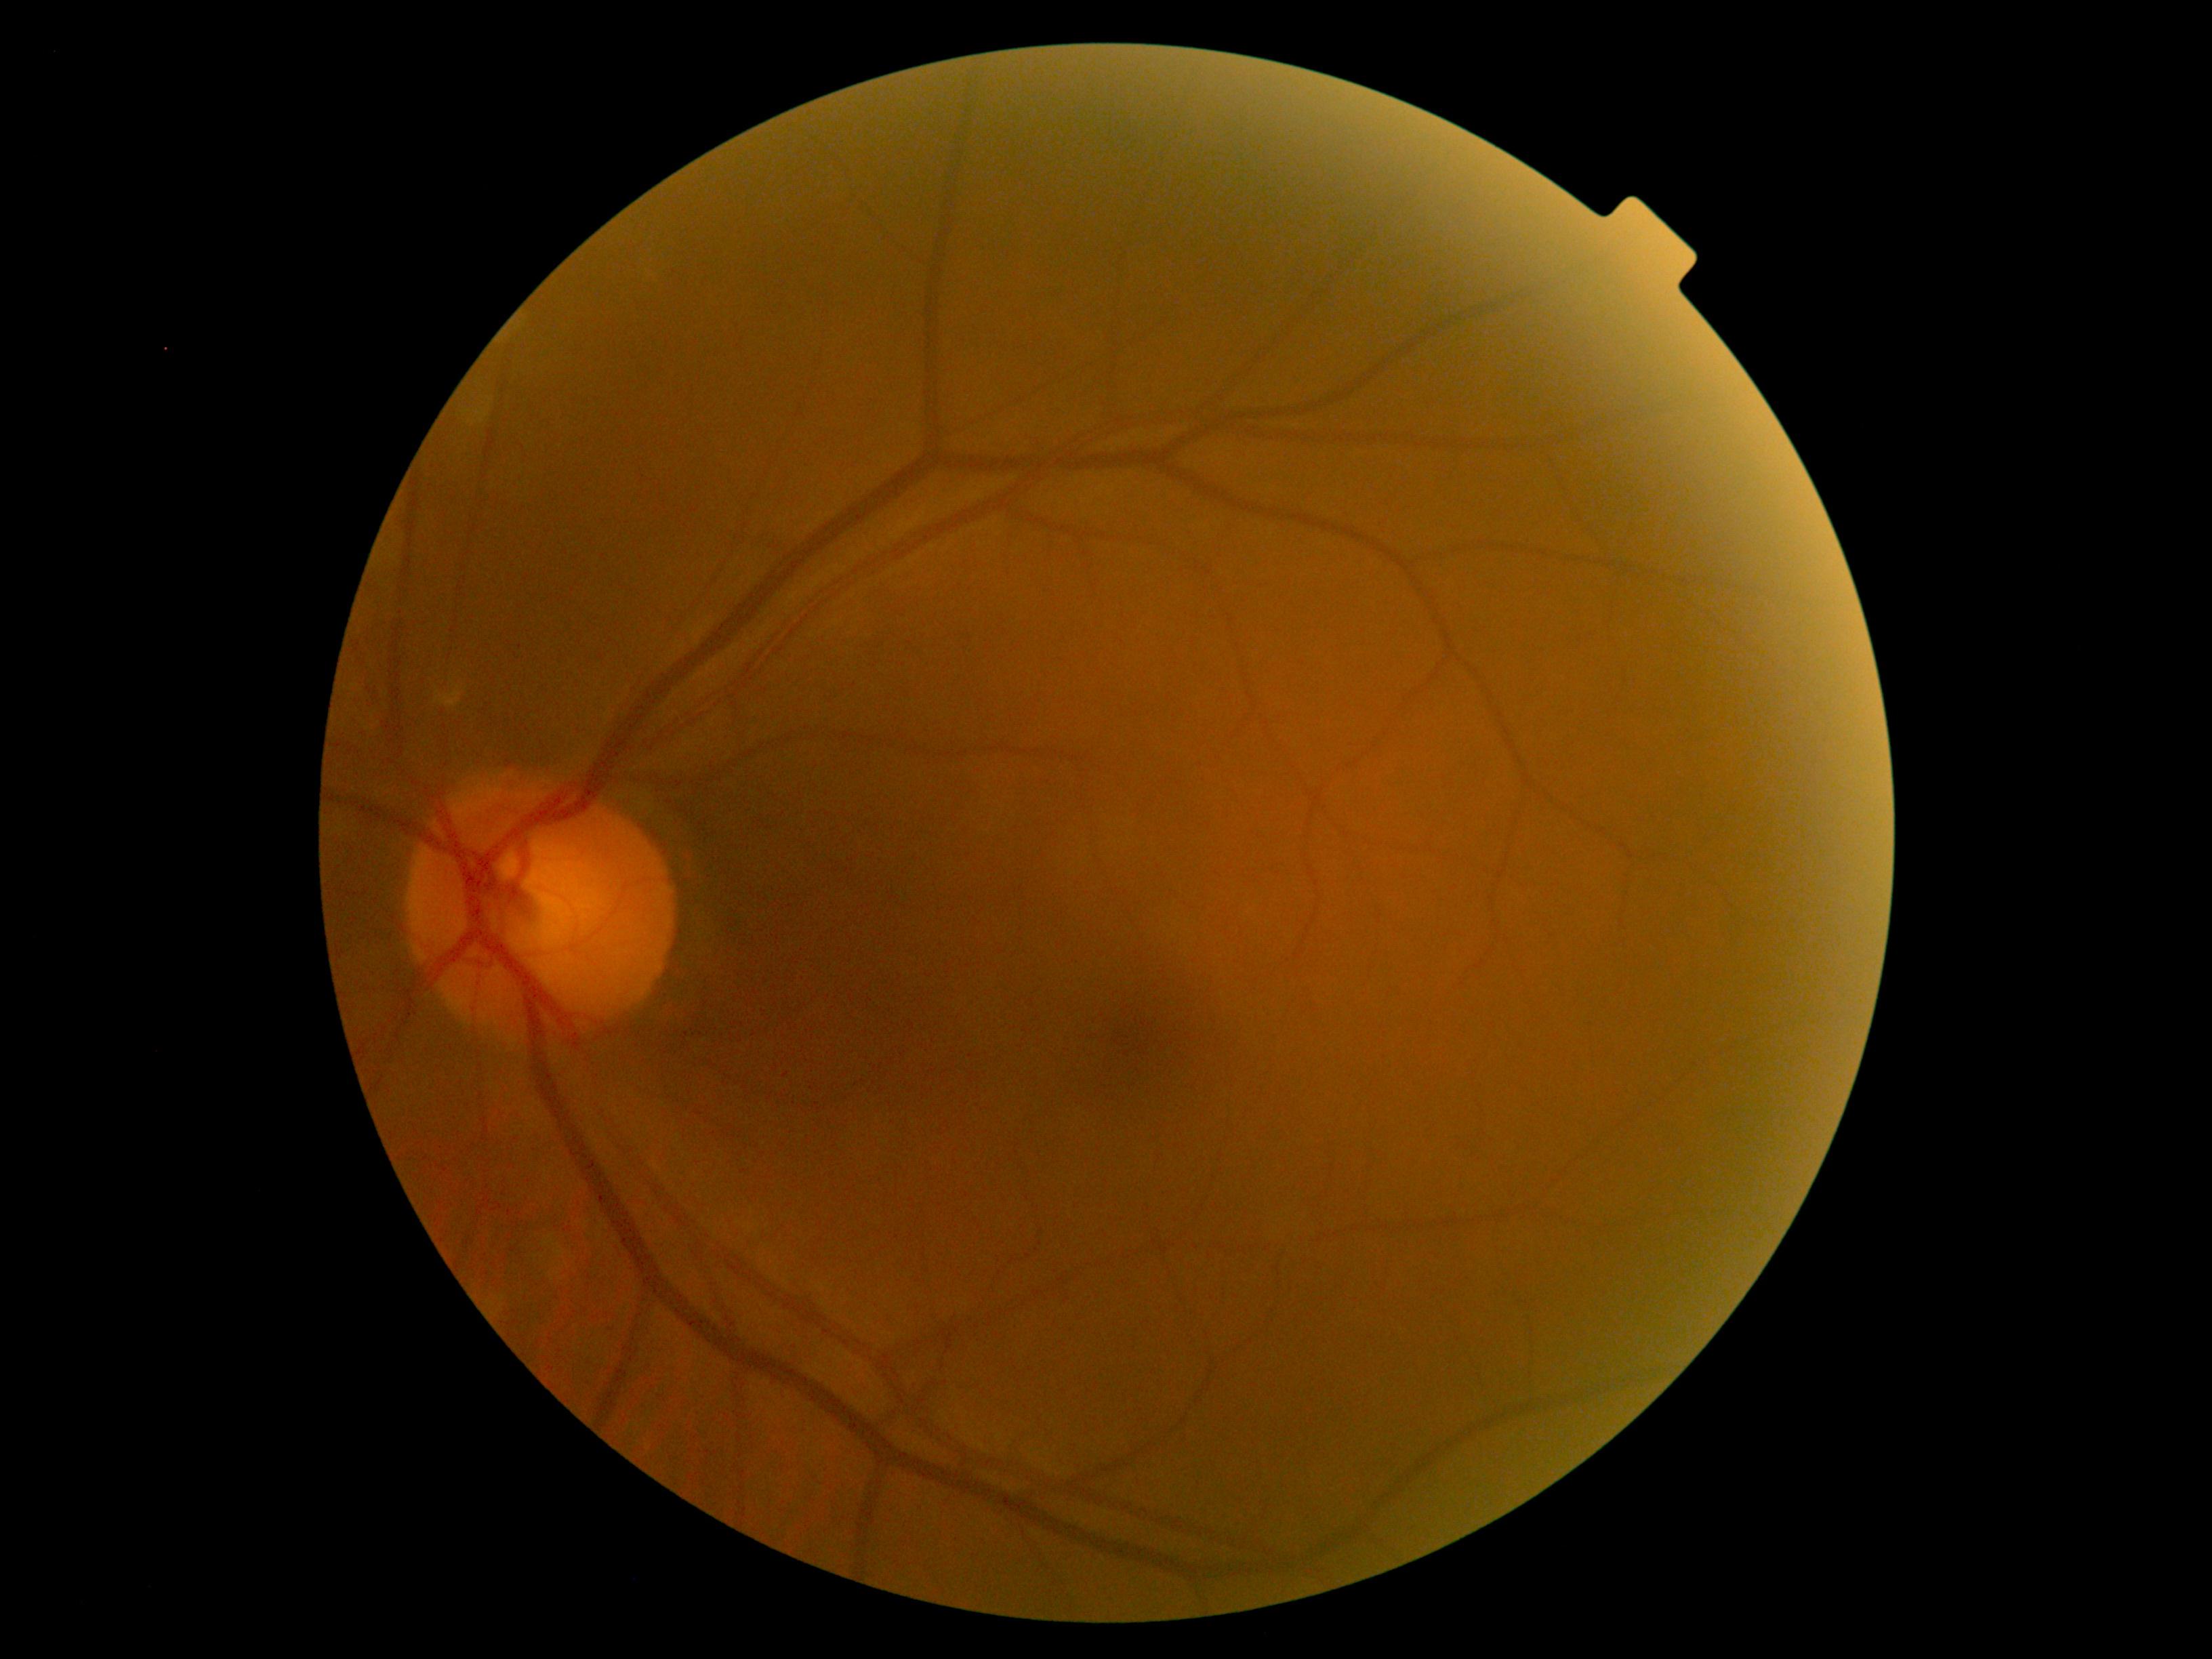

DR impression: no DR findings, diabetic retinopathy: 0.